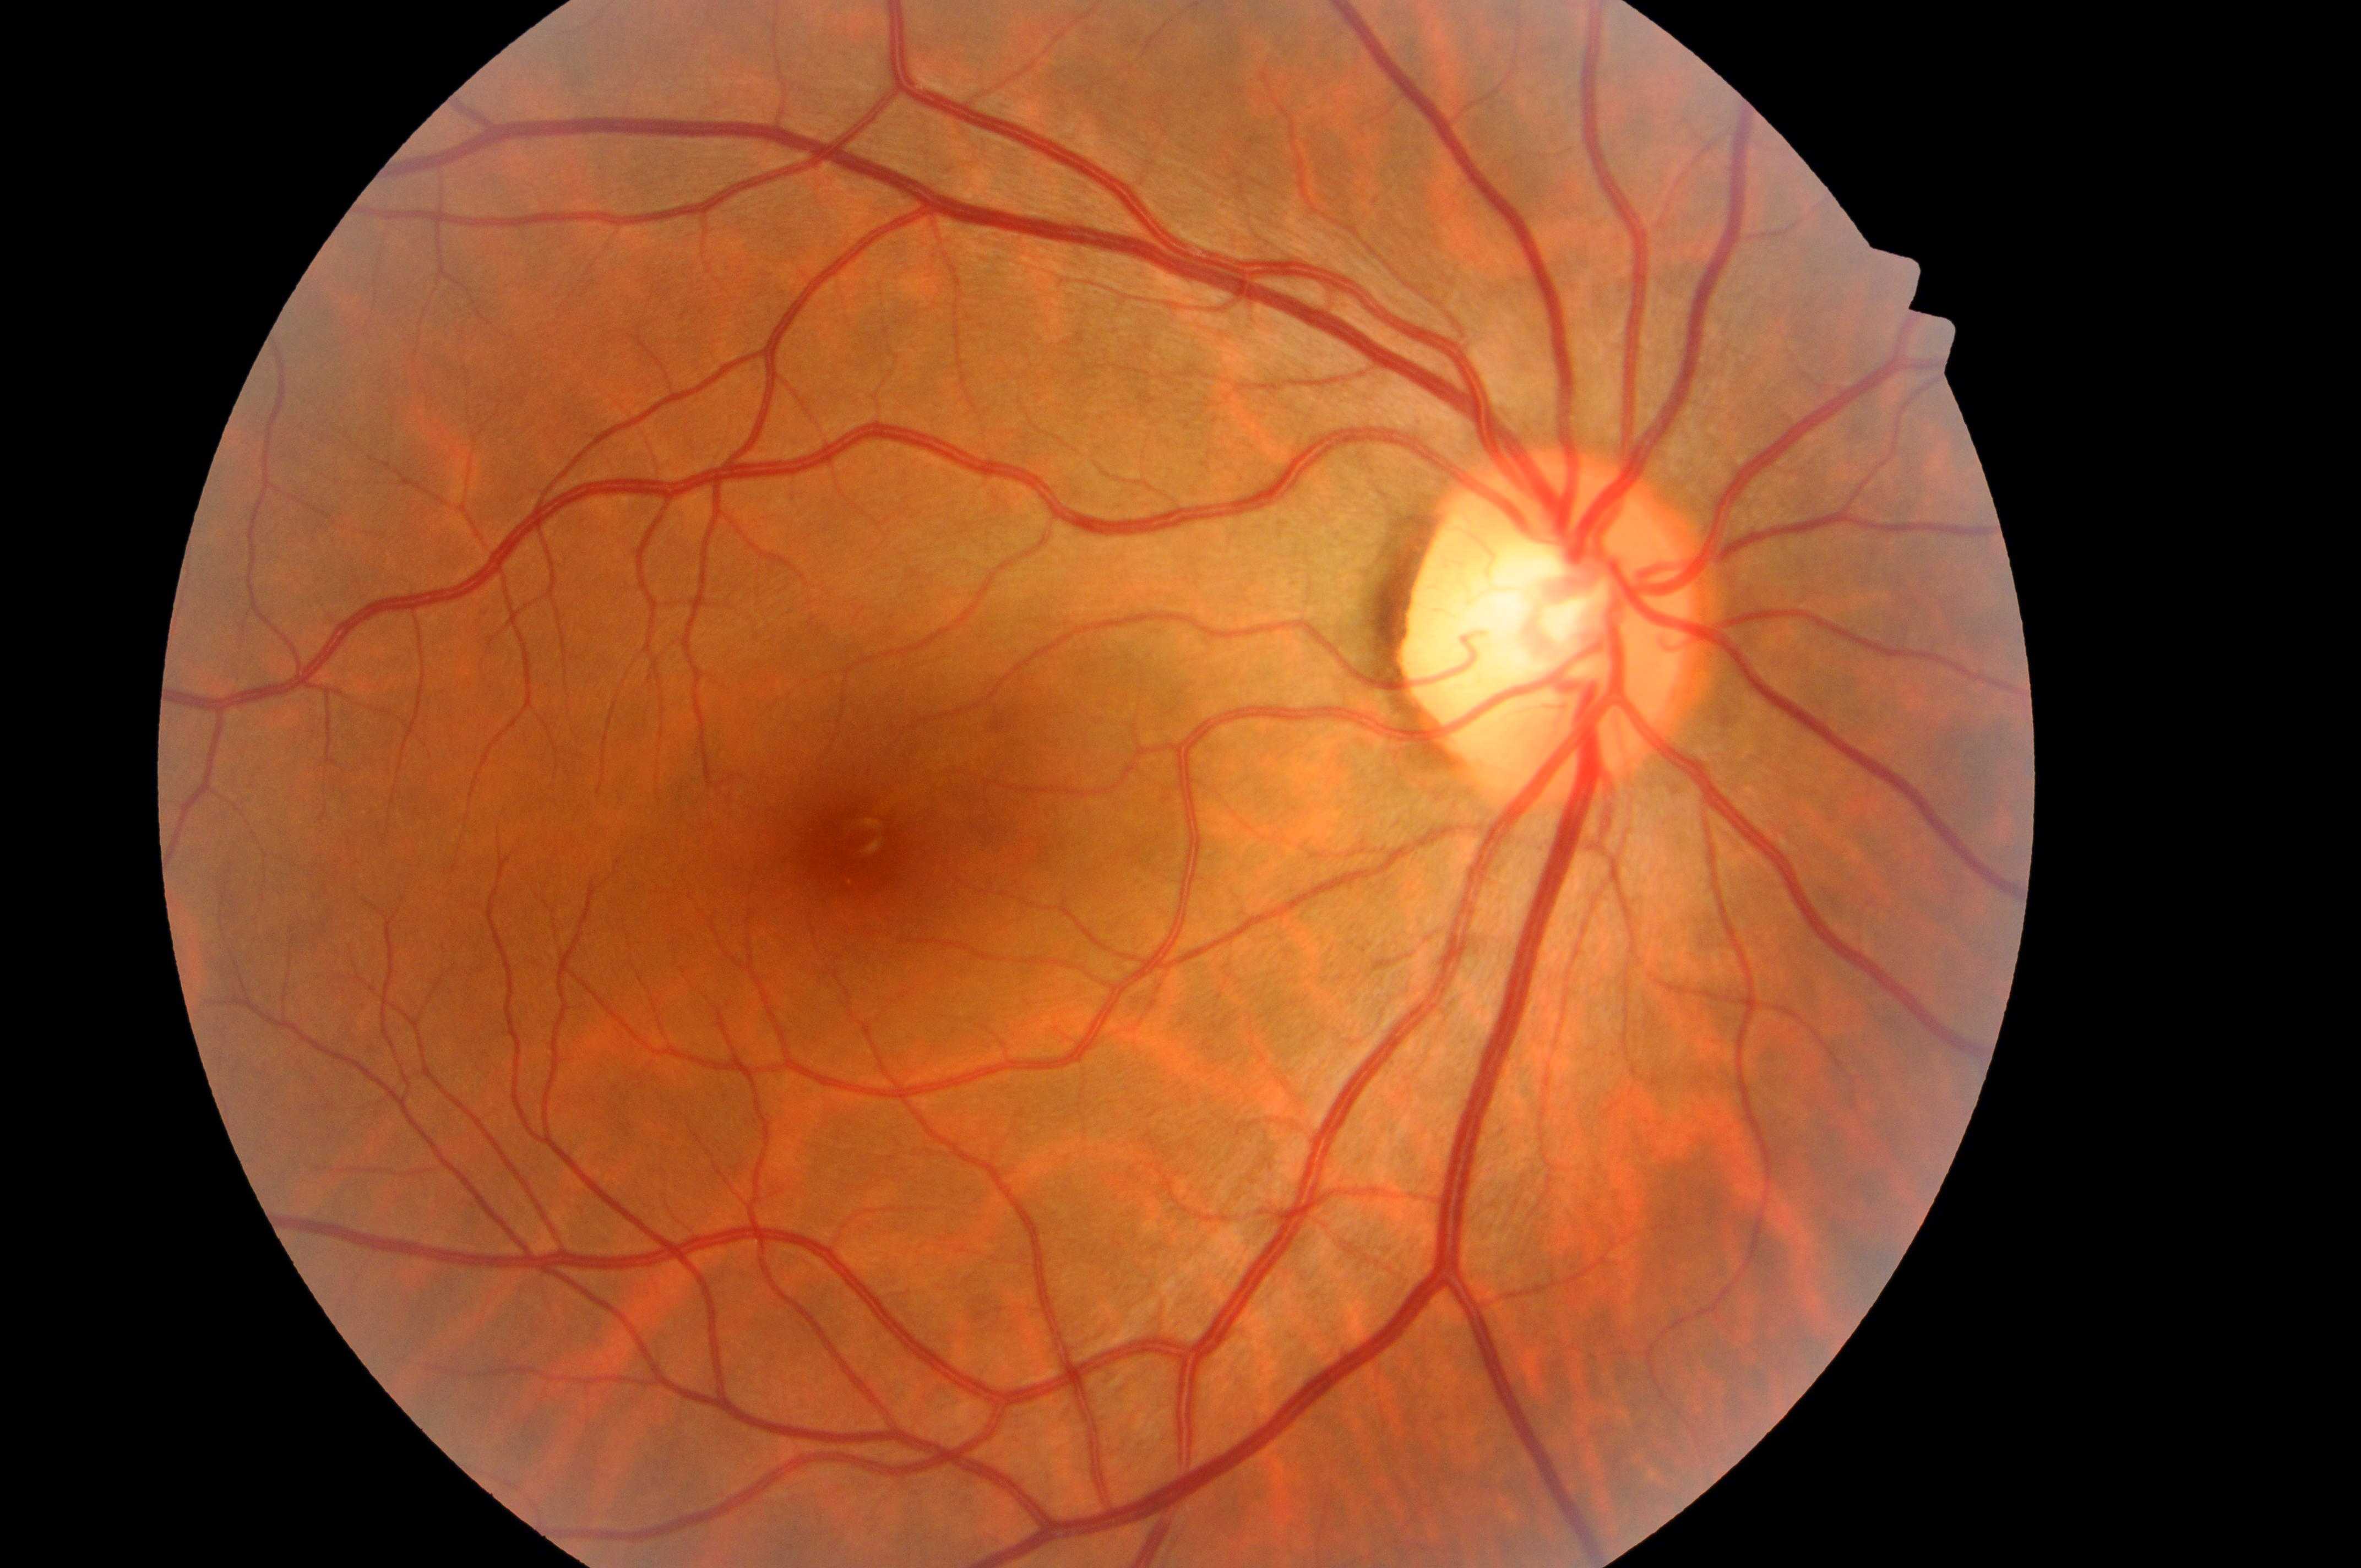   dr_impression: No DR or DME findings
  eye: right
  dme_grade: 0
  dr_grade: 0
  optic_disc: x=1543, y=635
  fovea: x=856, y=853